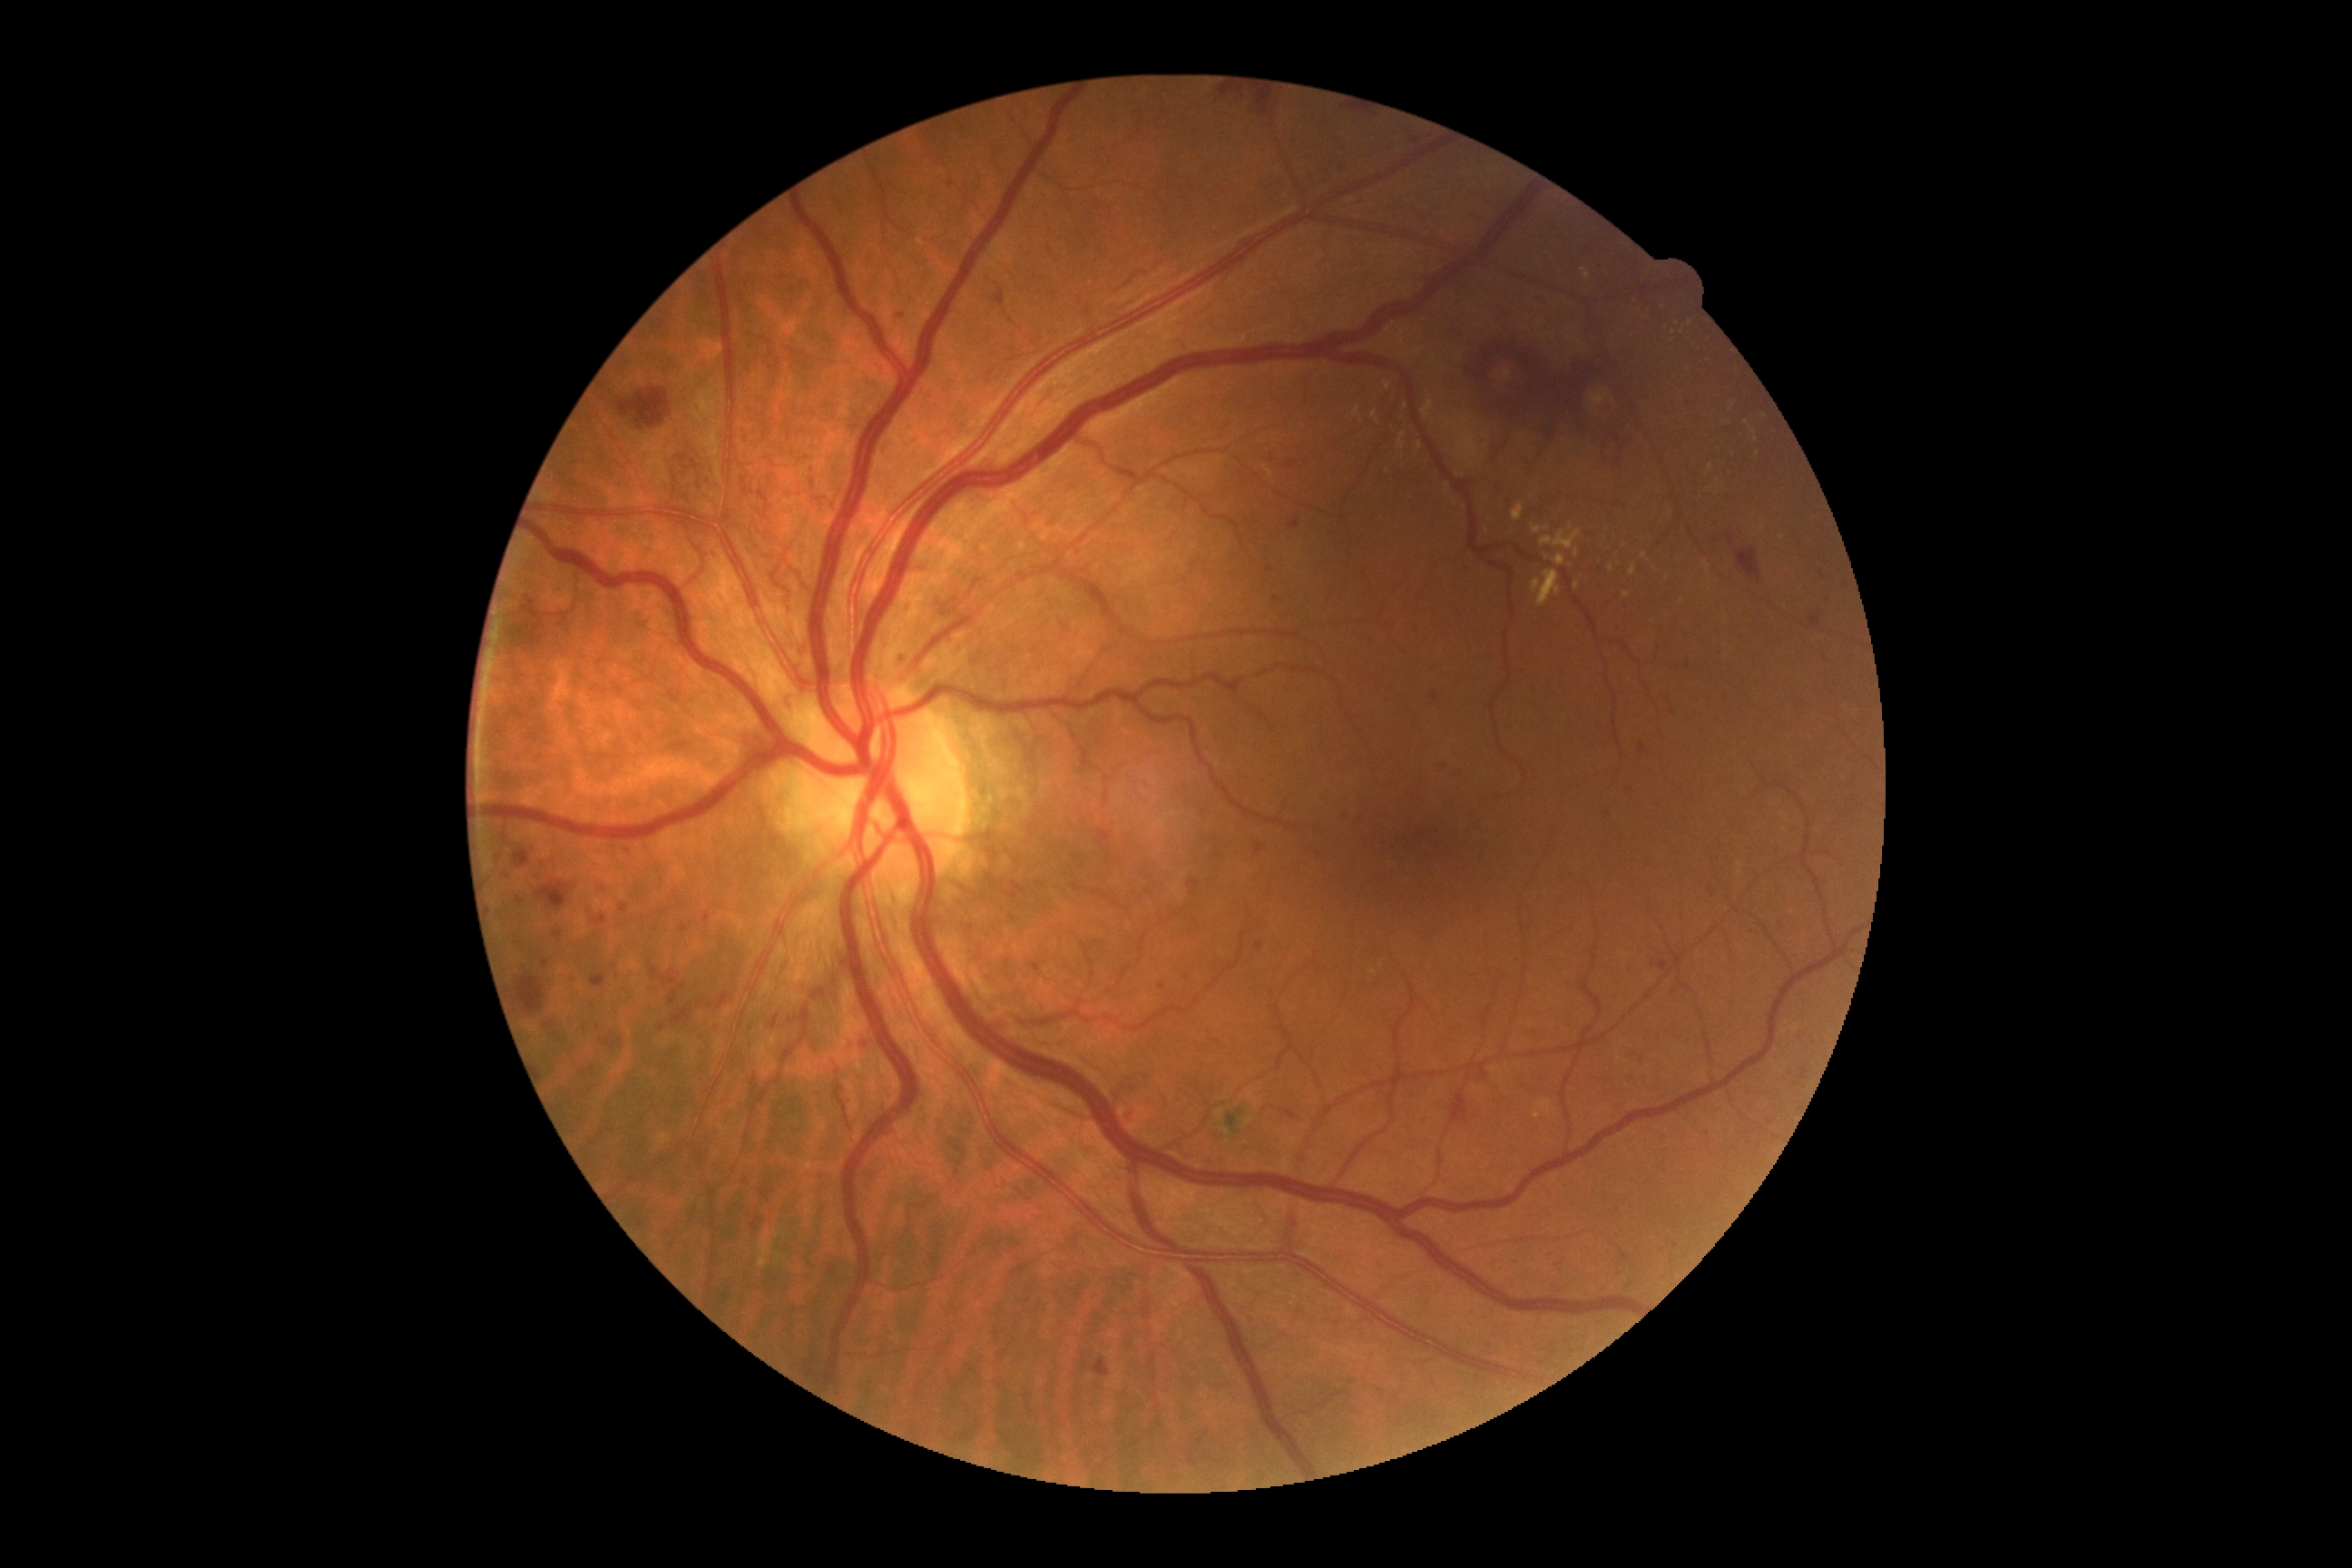
DR stage: grade 3 (severe NPDR); non-proliferative diabetic retinopathy. EXs include lesions at {"left": 1705, "top": 562, "right": 1710, "bottom": 573}, {"left": 1533, "top": 580, "right": 1542, "bottom": 593}, {"left": 1264, "top": 466, "right": 1273, "bottom": 476}, {"left": 1531, "top": 524, "right": 1542, "bottom": 534}, {"left": 1353, "top": 407, "right": 1360, "bottom": 416}, {"left": 1534, "top": 1099, "right": 1554, "bottom": 1119}, {"left": 1422, "top": 402, "right": 1433, "bottom": 416}, {"left": 1540, "top": 529, "right": 1582, "bottom": 551}, {"left": 1574, "top": 549, "right": 1580, "bottom": 558}, {"left": 1609, "top": 565, "right": 1614, "bottom": 573}, {"left": 1629, "top": 565, "right": 1636, "bottom": 576}. EXs (small, approximate centers) near (x=1733, y=406), (x=1711, y=467), (x=1644, y=555), (x=1571, y=529), (x=1756, y=440), (x=1763, y=417). MAs include lesions at {"left": 863, "top": 1039, "right": 870, "bottom": 1050}, {"left": 1533, "top": 1032, "right": 1540, "bottom": 1041}, {"left": 514, "top": 943, "right": 522, "bottom": 946}, {"left": 1473, "top": 1073, "right": 1485, "bottom": 1084}, {"left": 1810, "top": 611, "right": 1821, "bottom": 629}, {"left": 554, "top": 930, "right": 564, "bottom": 937}, {"left": 504, "top": 872, "right": 509, "bottom": 881}, {"left": 1429, "top": 692, "right": 1440, "bottom": 703}, {"left": 1660, "top": 961, "right": 1669, "bottom": 972}. MAs (small, approximate centers) near (x=1289, y=465), (x=542, y=862), (x=1783, y=926), (x=1828, y=602), (x=1188, y=978), (x=850, y=1046), (x=951, y=185), (x=598, y=1028), (x=1319, y=855).